Davis DR grading: 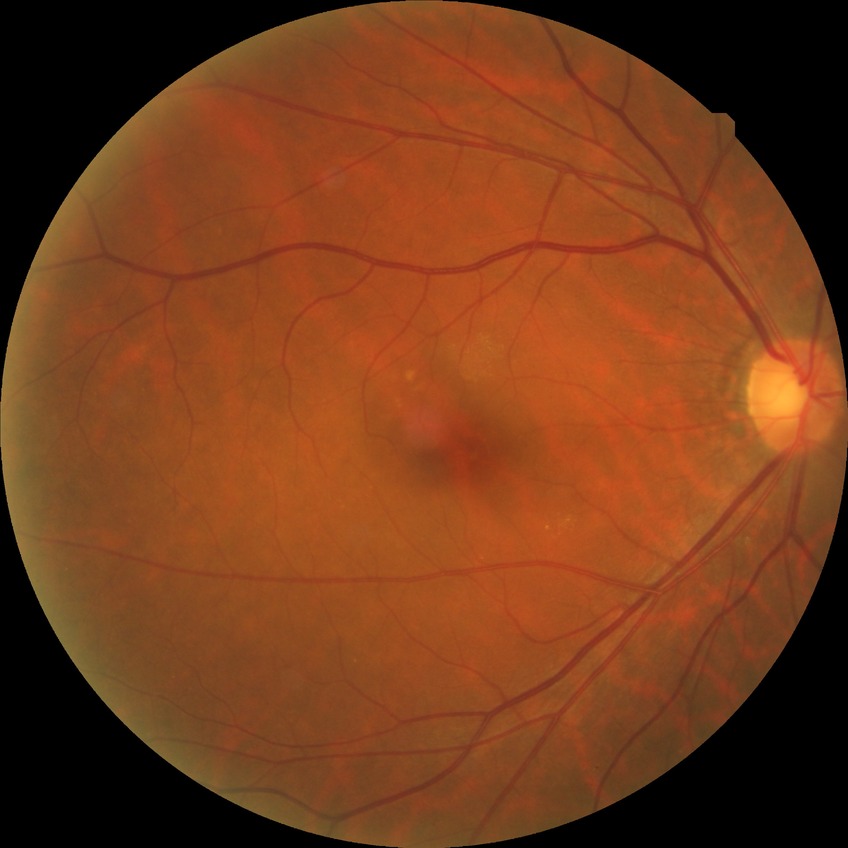

diabetic retinopathy (DR)@no diabetic retinopathy (NDR).